Retinal fundus photograph.
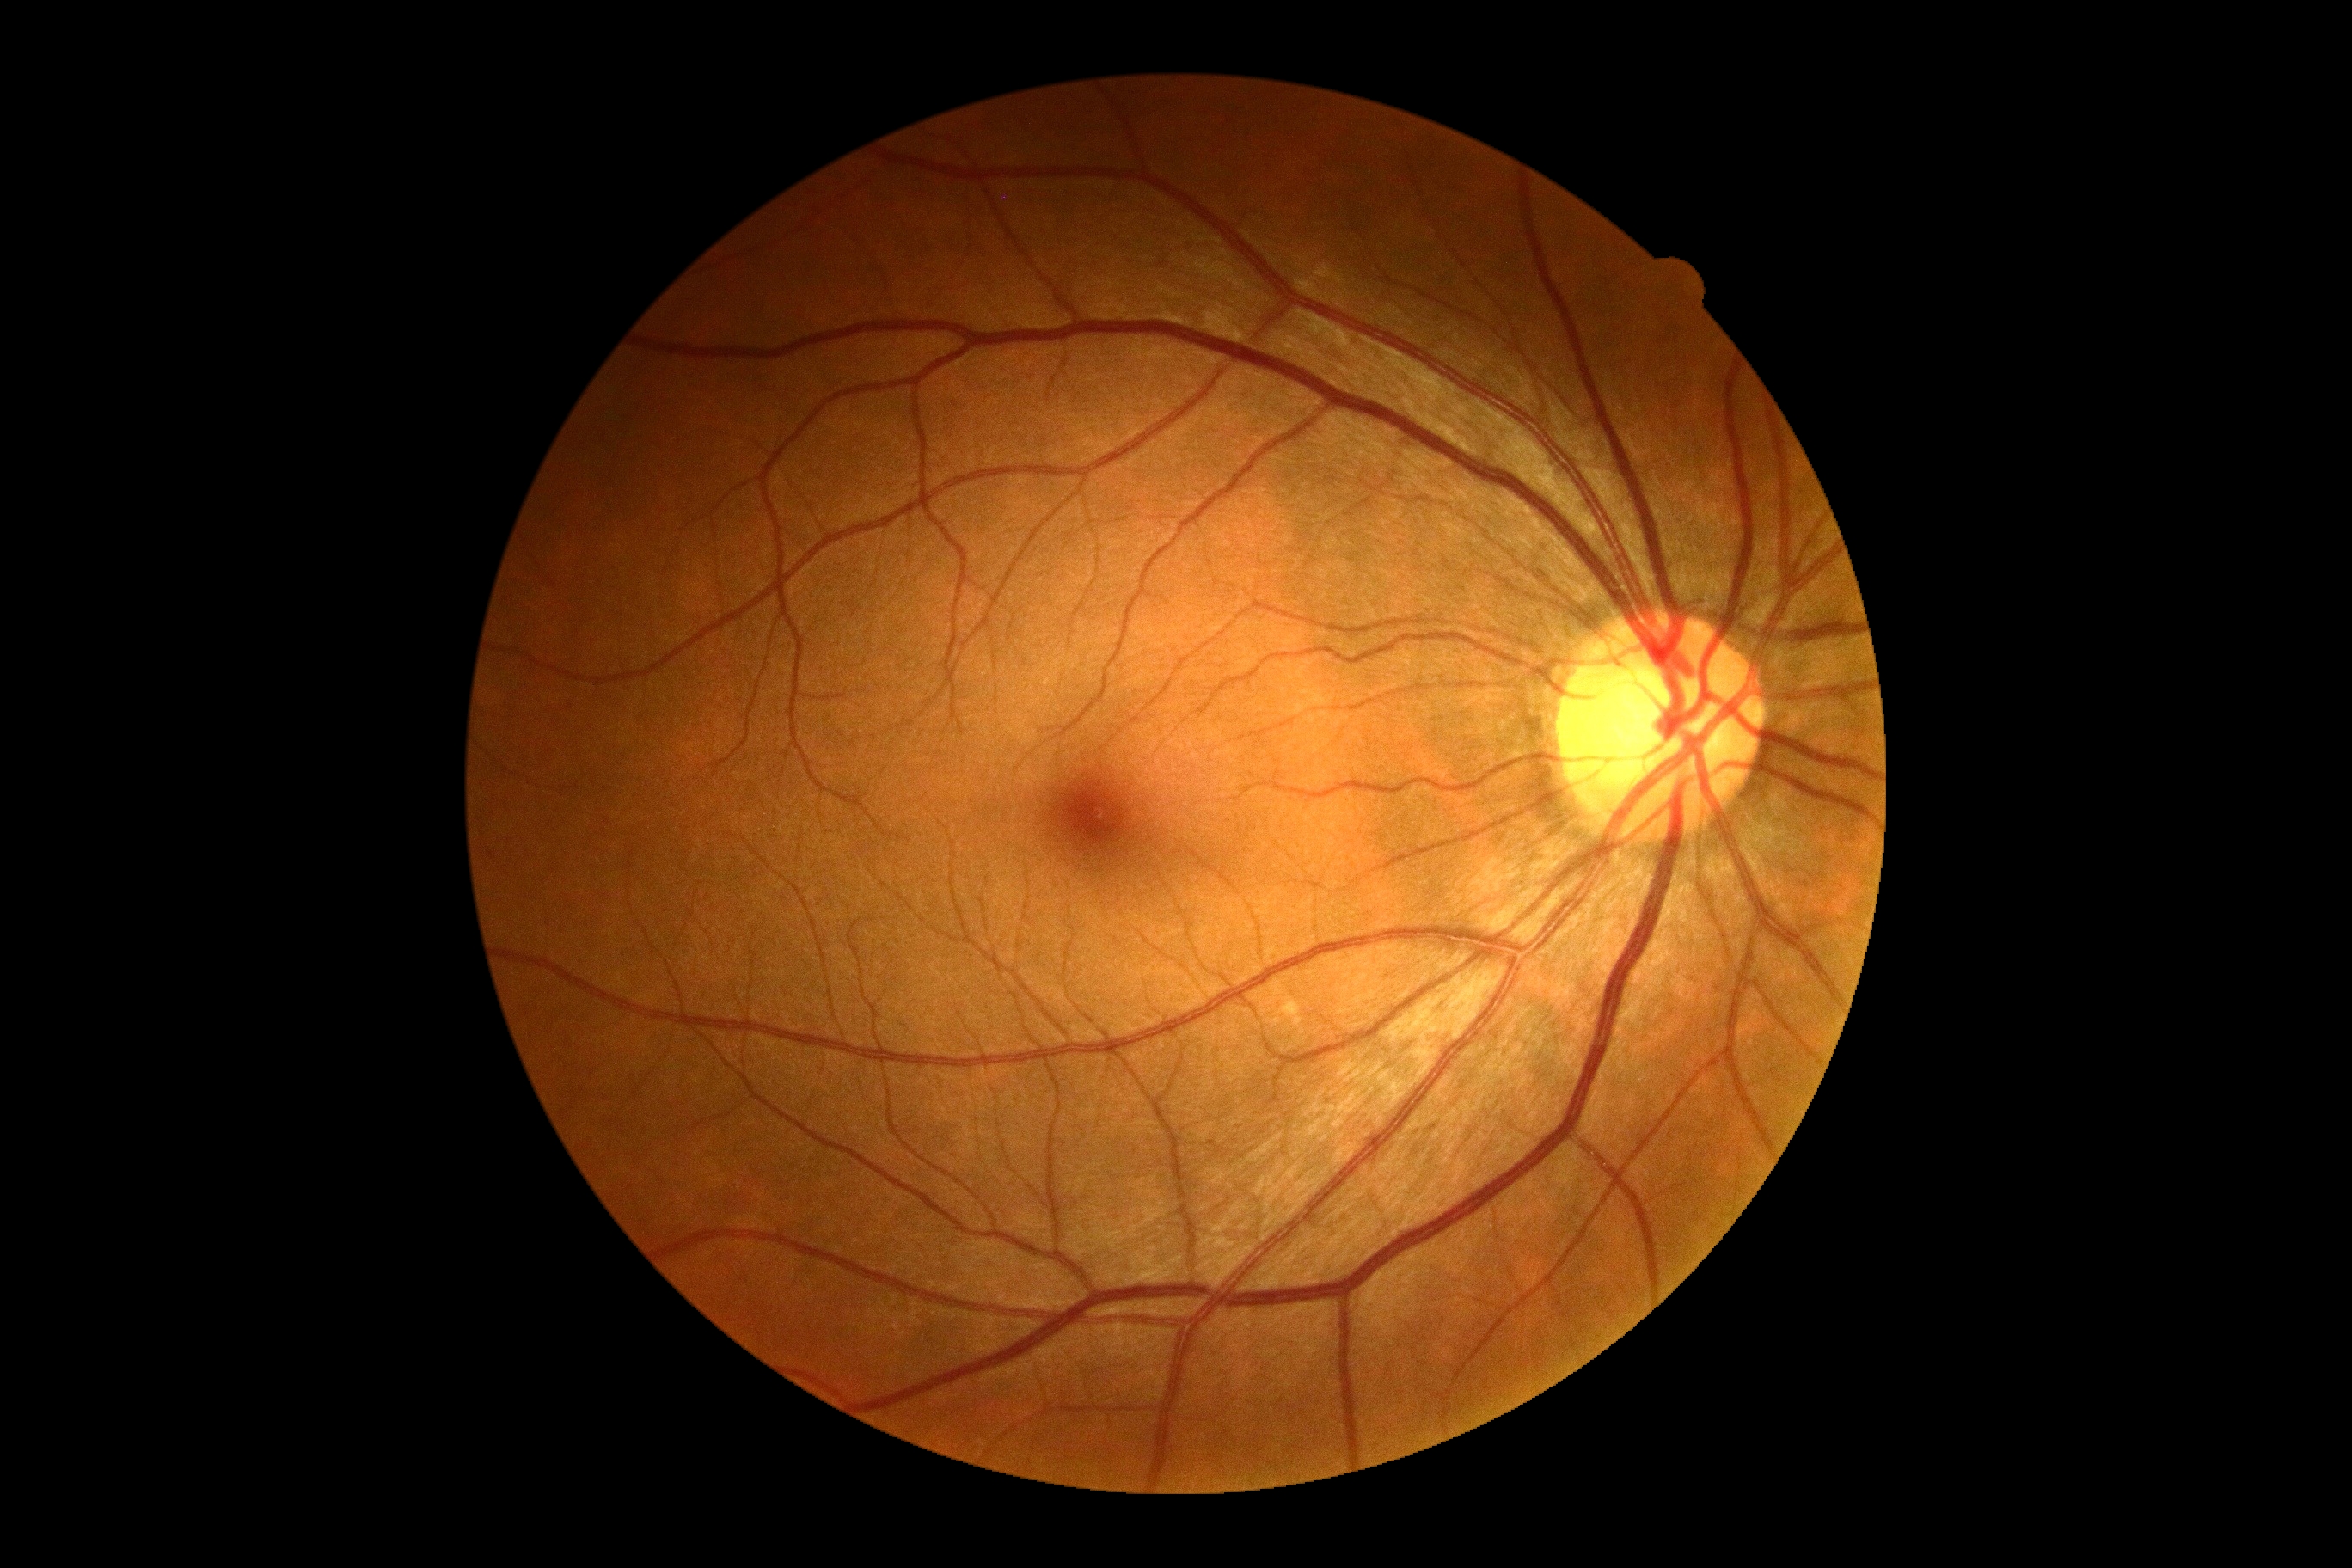 dr_grade: no apparent retinopathy (grade 0) — no visible signs of diabetic retinopathy